45° FOV, image size 2352x1568: 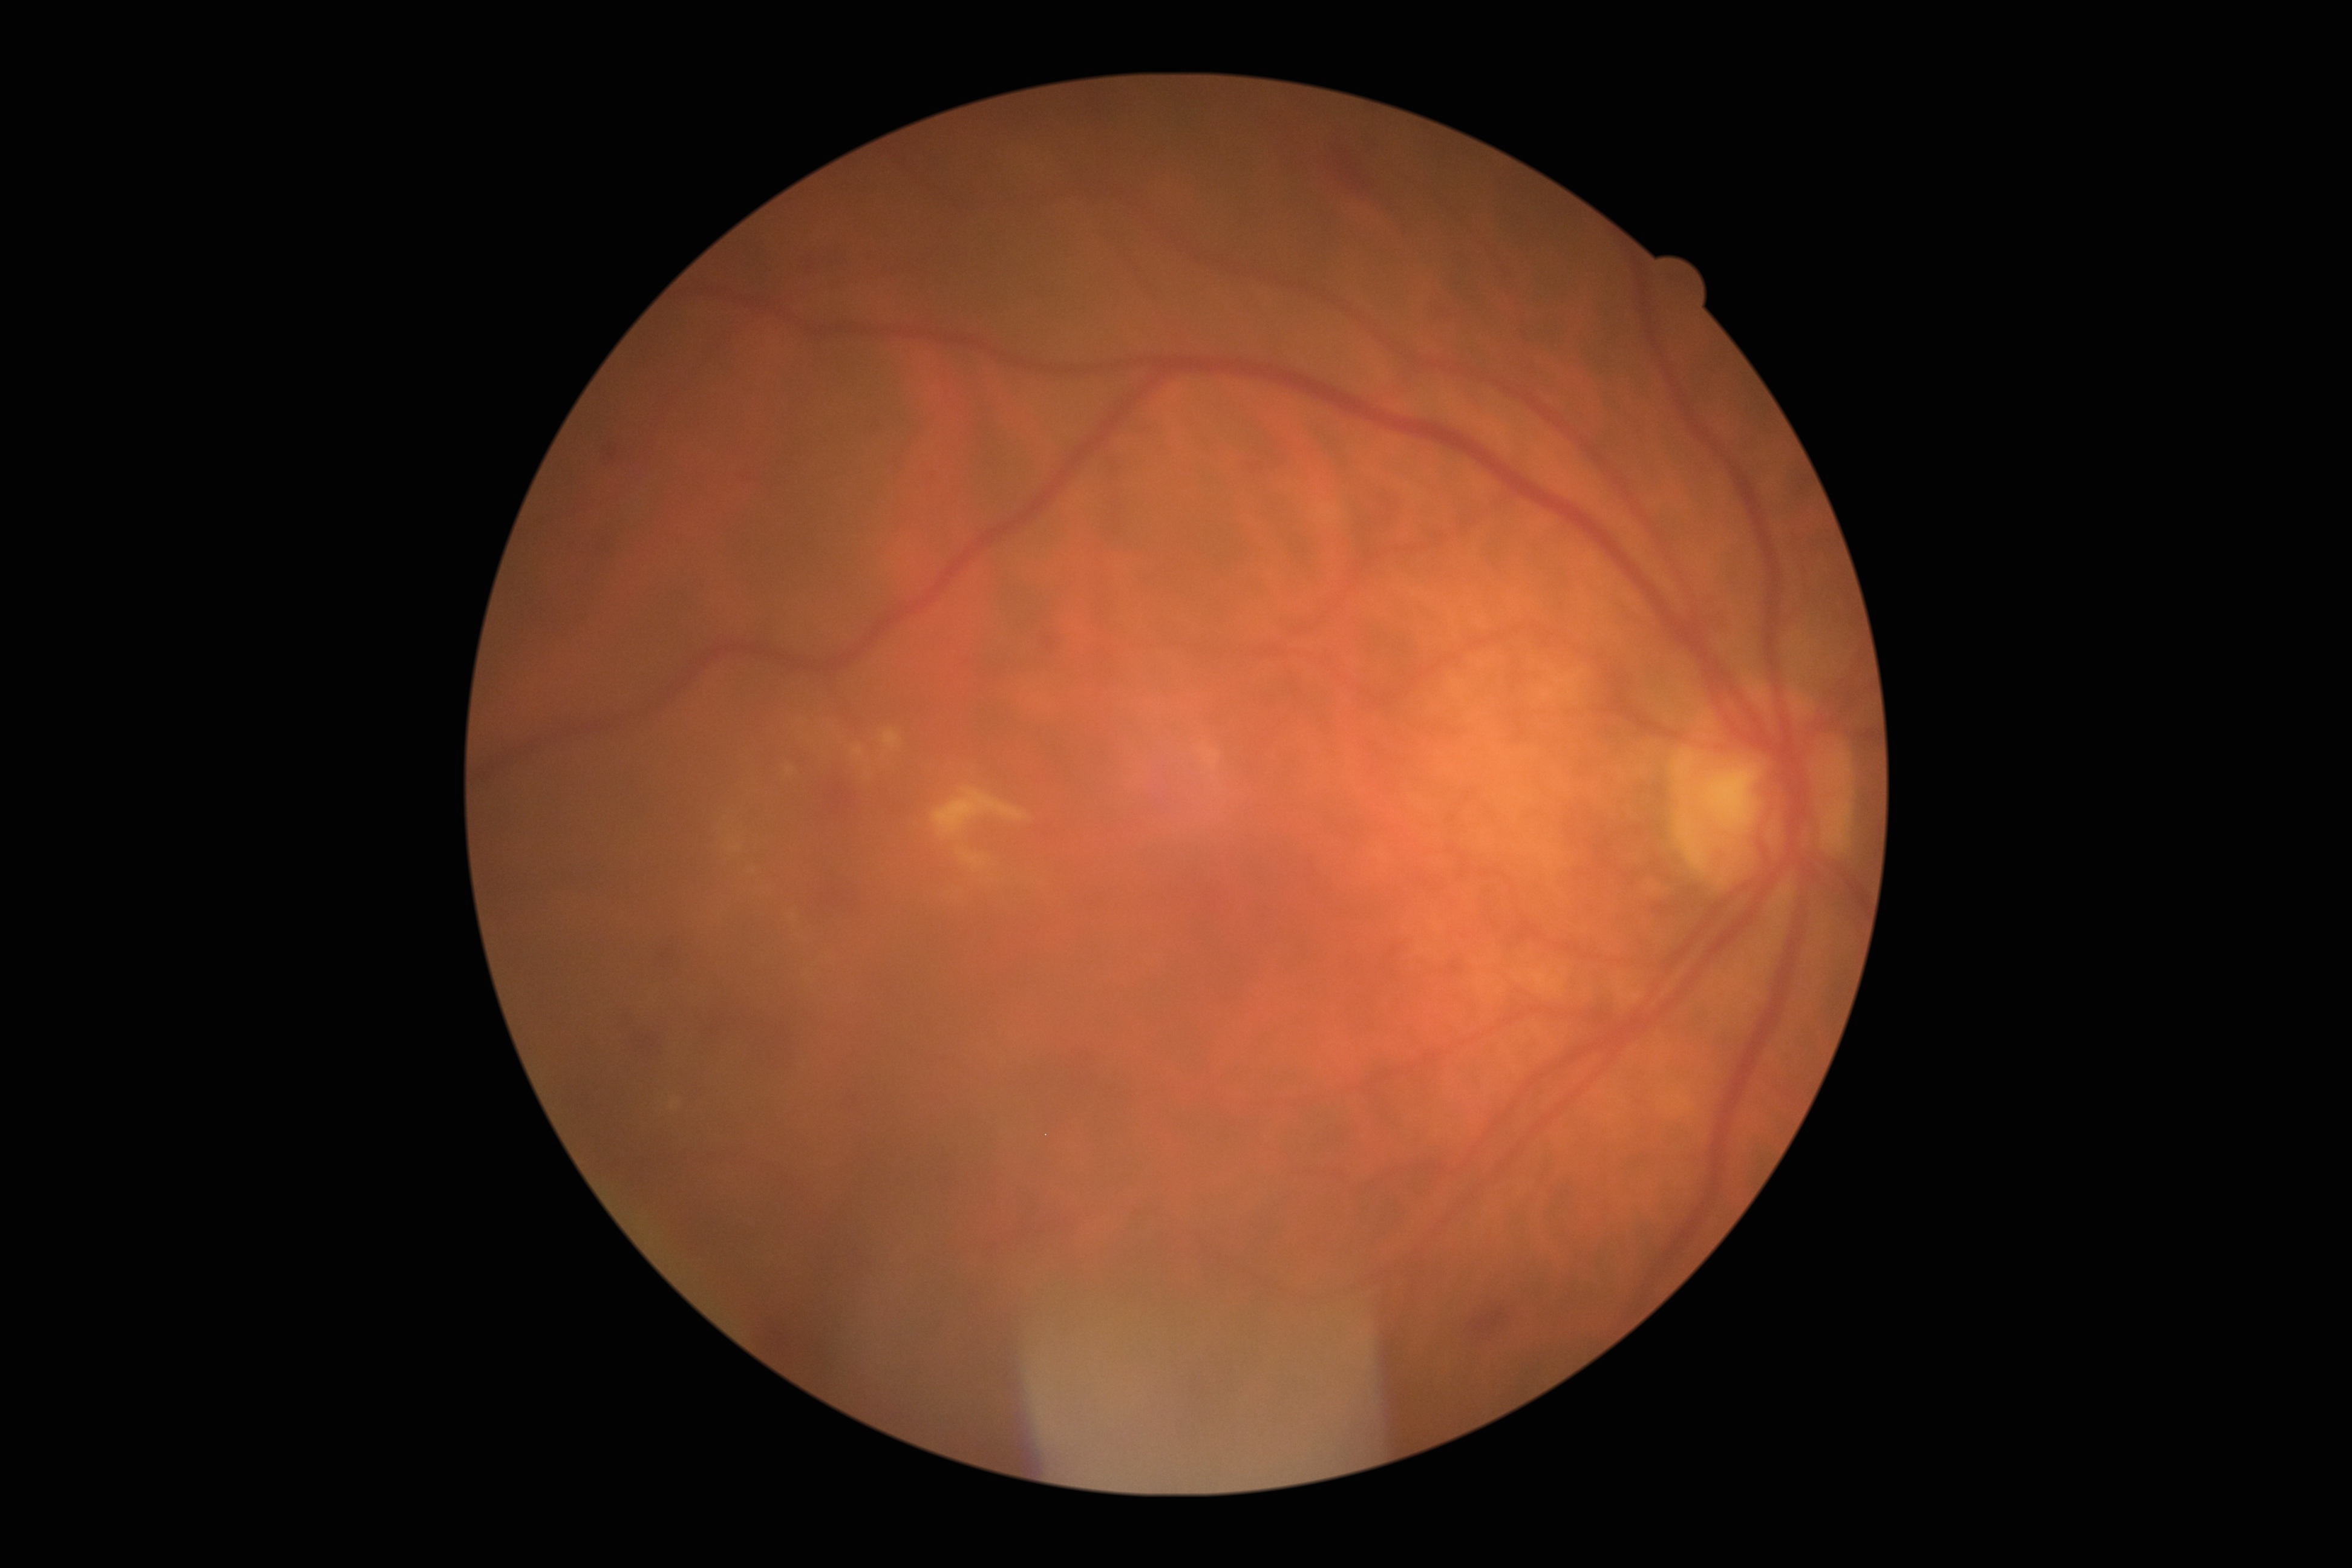

diabetic retinopathy grade=2.